Diabetic retinopathy graded by the modified Davis classification — 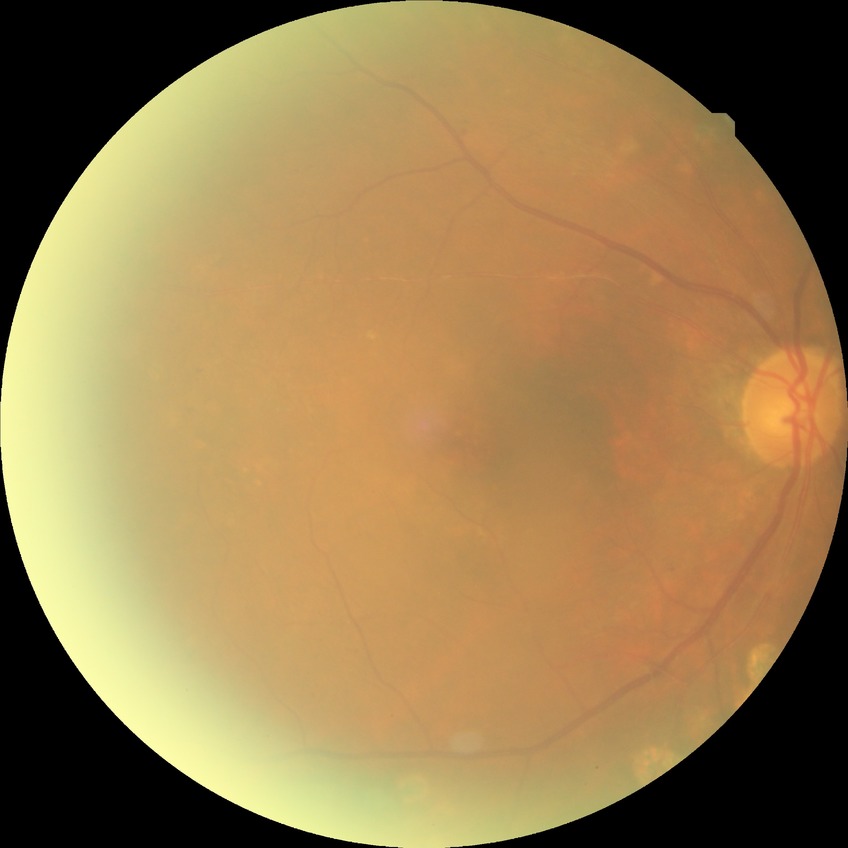

Assessment:
– DR stage: PDR